45 degree fundus photograph. Fundus photo. 848x848px.
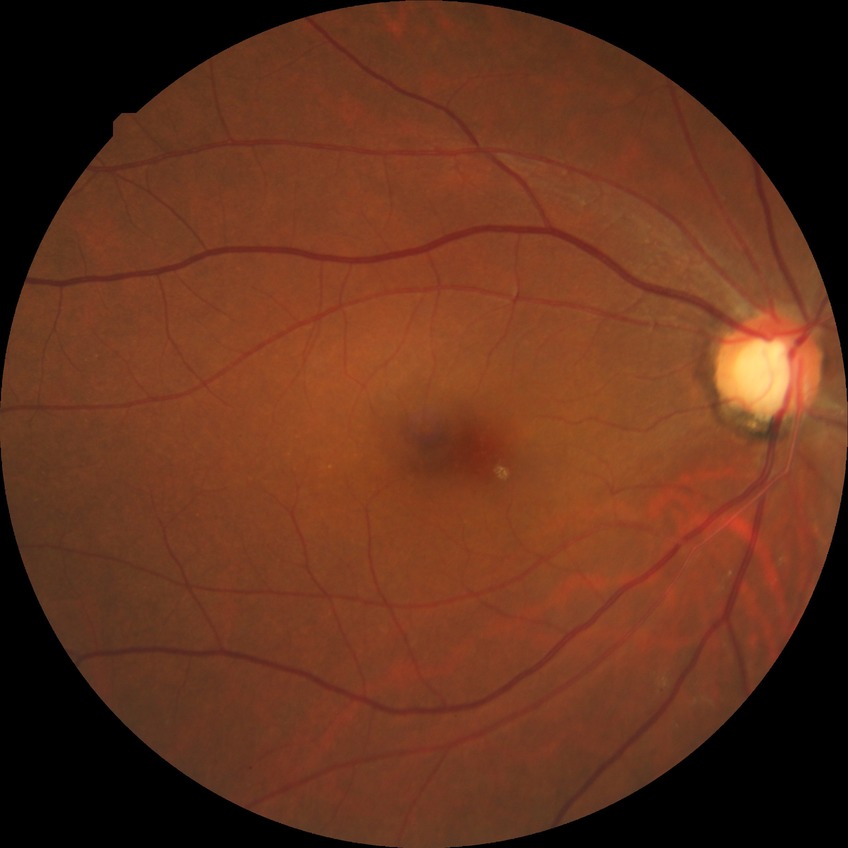

Retinopathy stage: no diabetic retinopathy.